1240 by 1240 pixels; wide-field fundus photograph of an infant; captured with the Phoenix ICON (100° field of view): 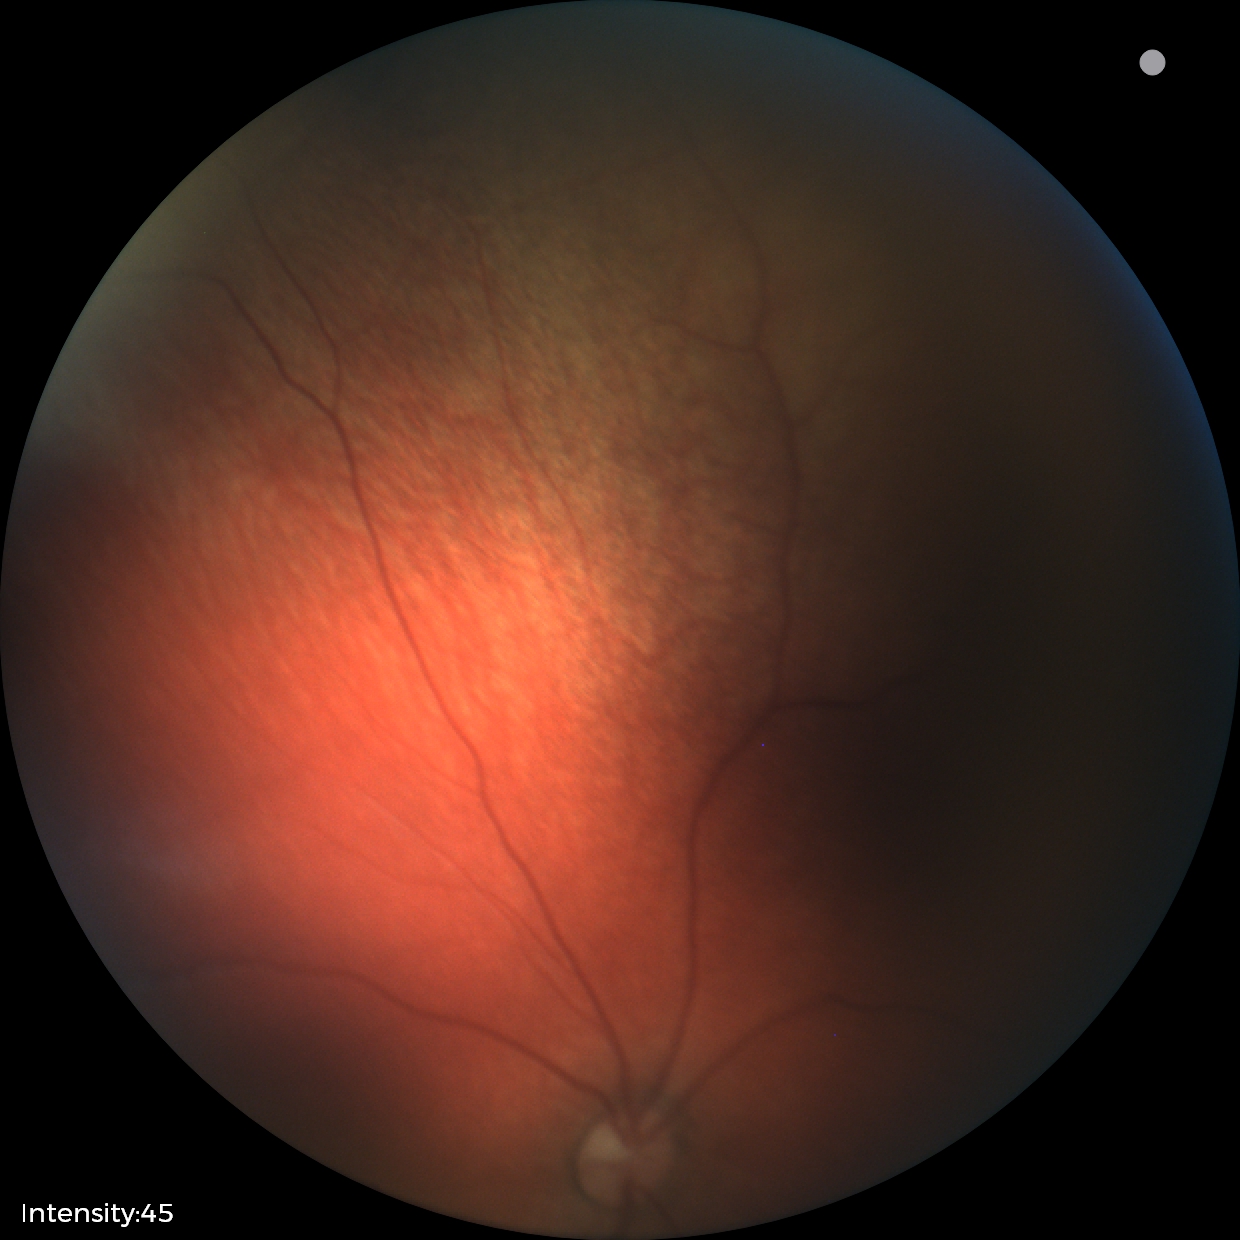
Examination with physiological retinal findings.